640 x 480 pixels · acquired on the Clarity RetCam 3 · wide-field fundus image from infant ROP screening.
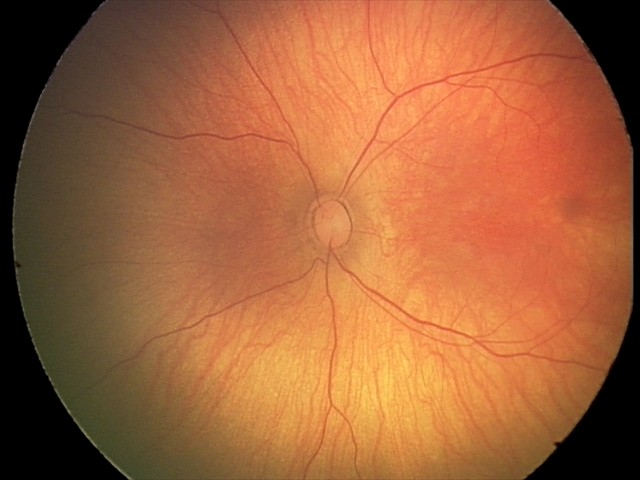 Screening examination with no abnormal retinal findings.